Color fundus photograph:
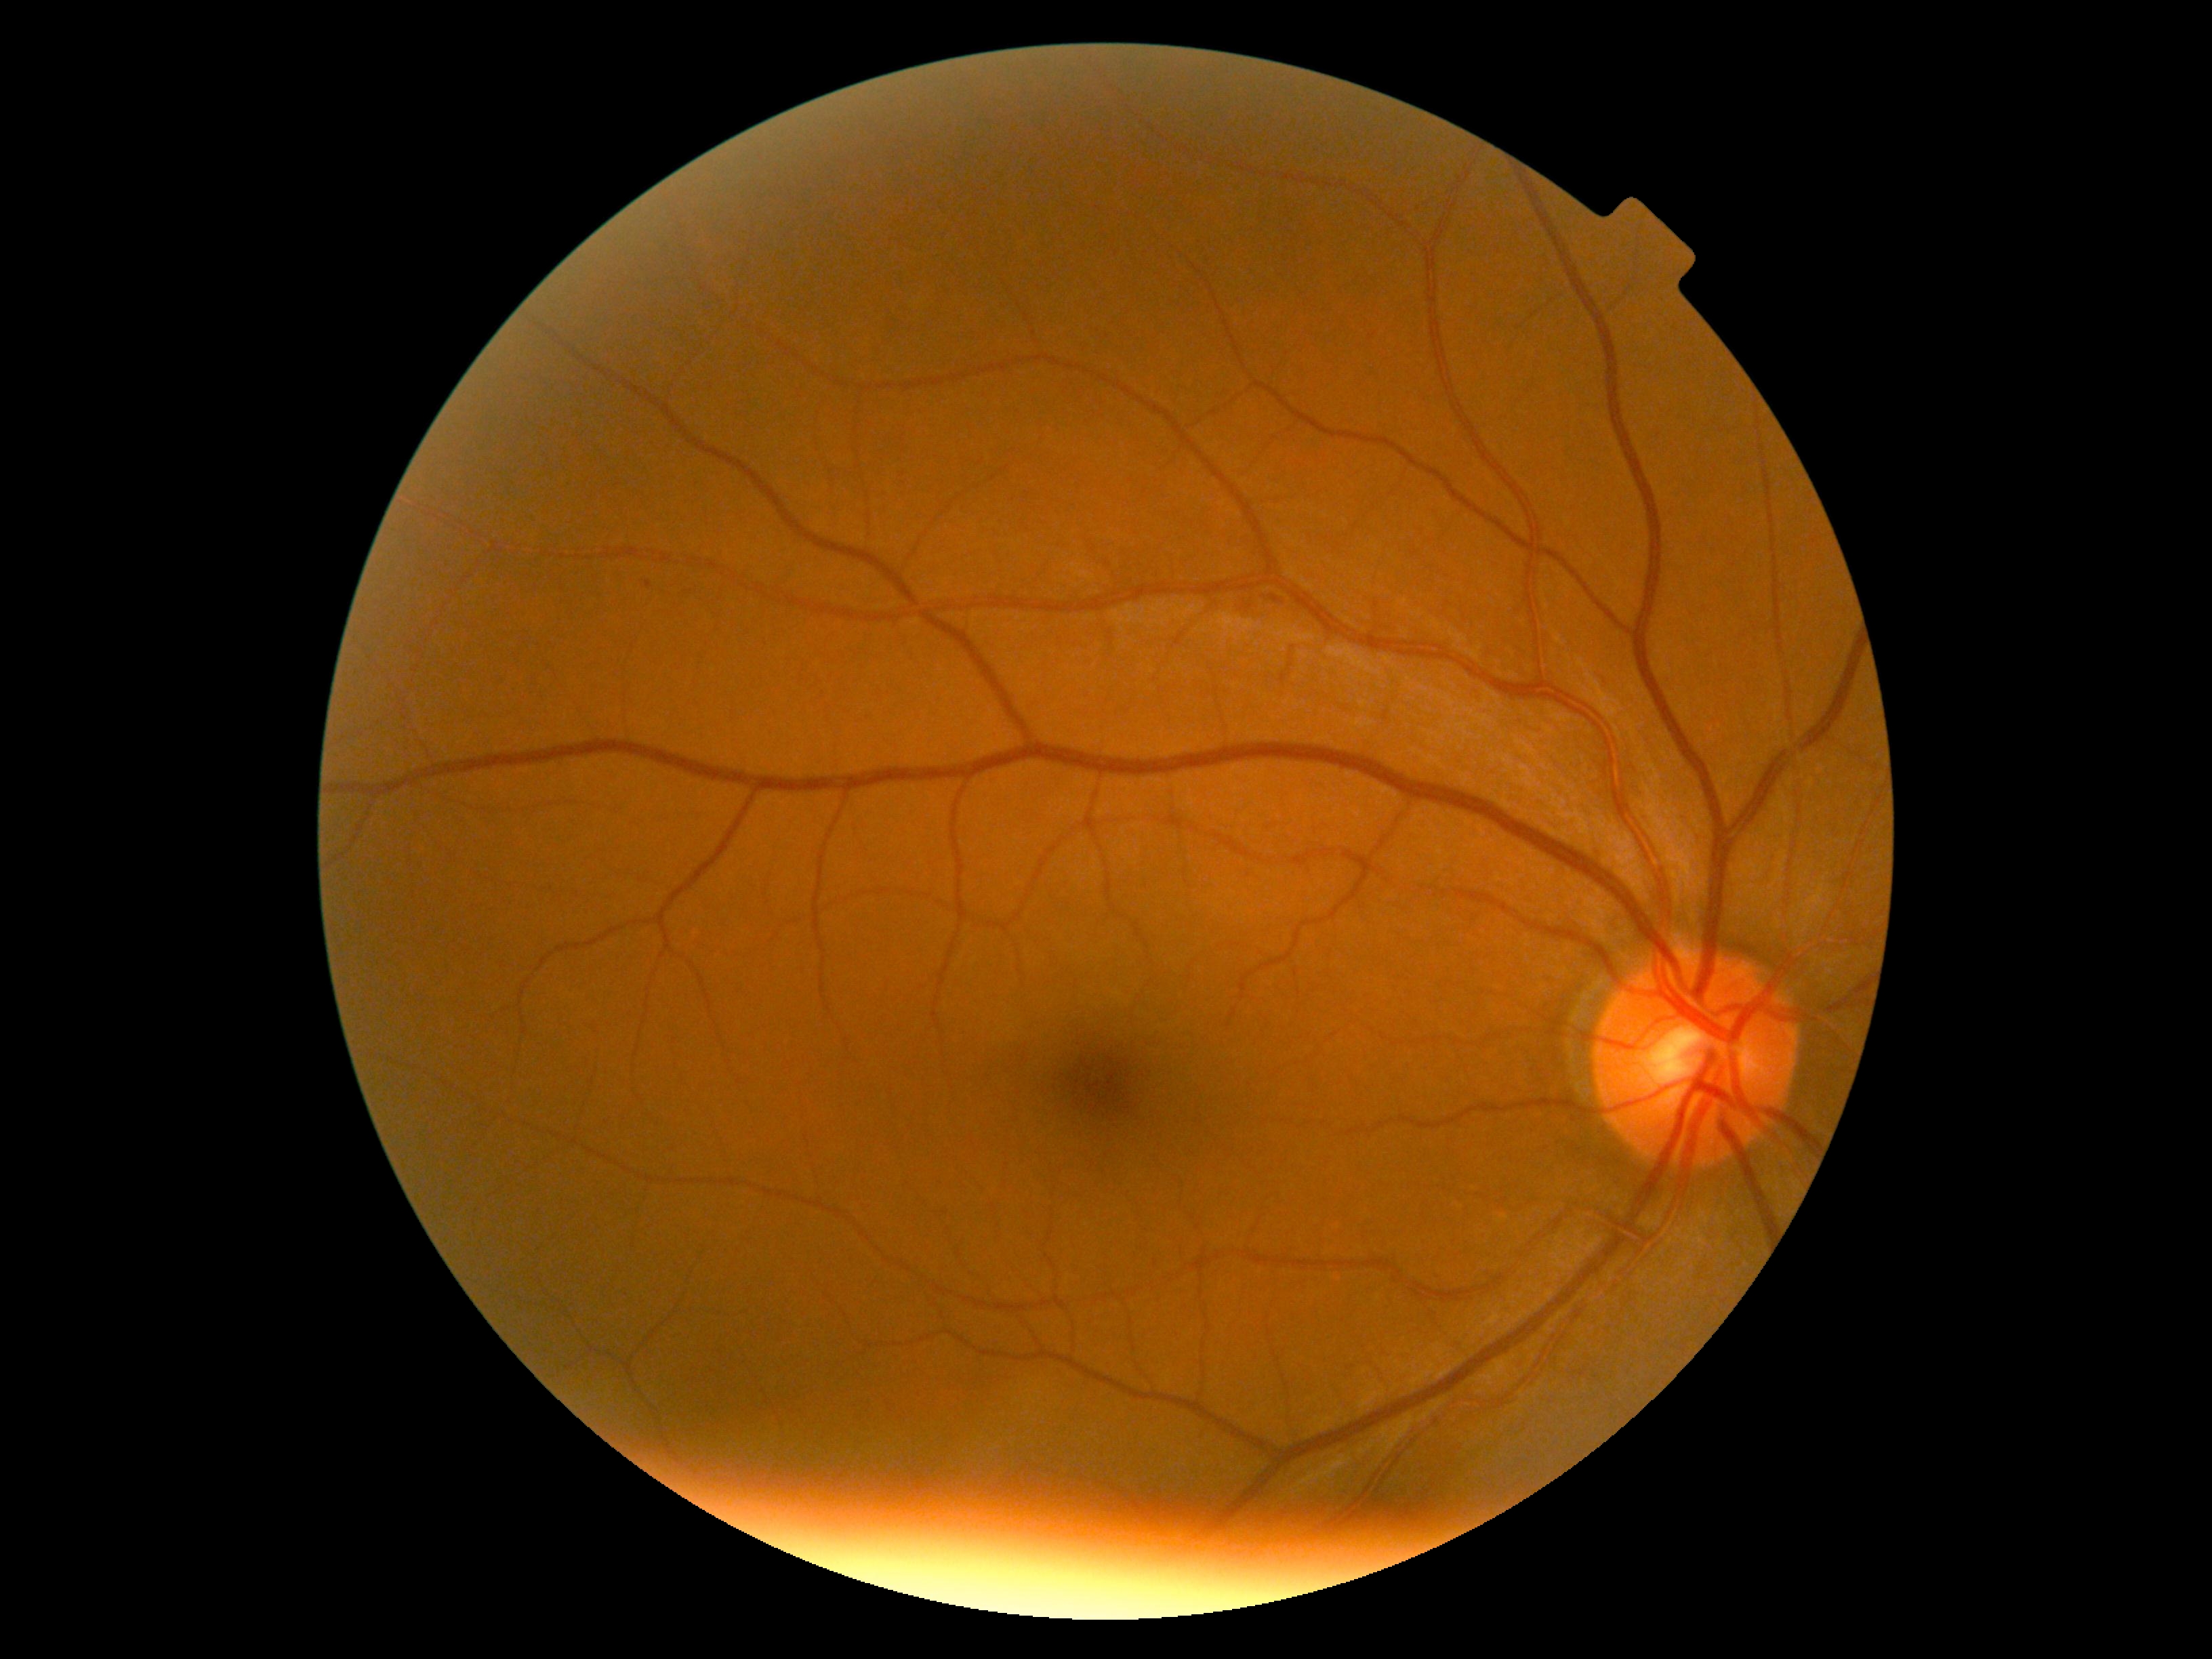
Retinopathy: grade 2 (moderate NPDR).